Retinal fundus photograph: 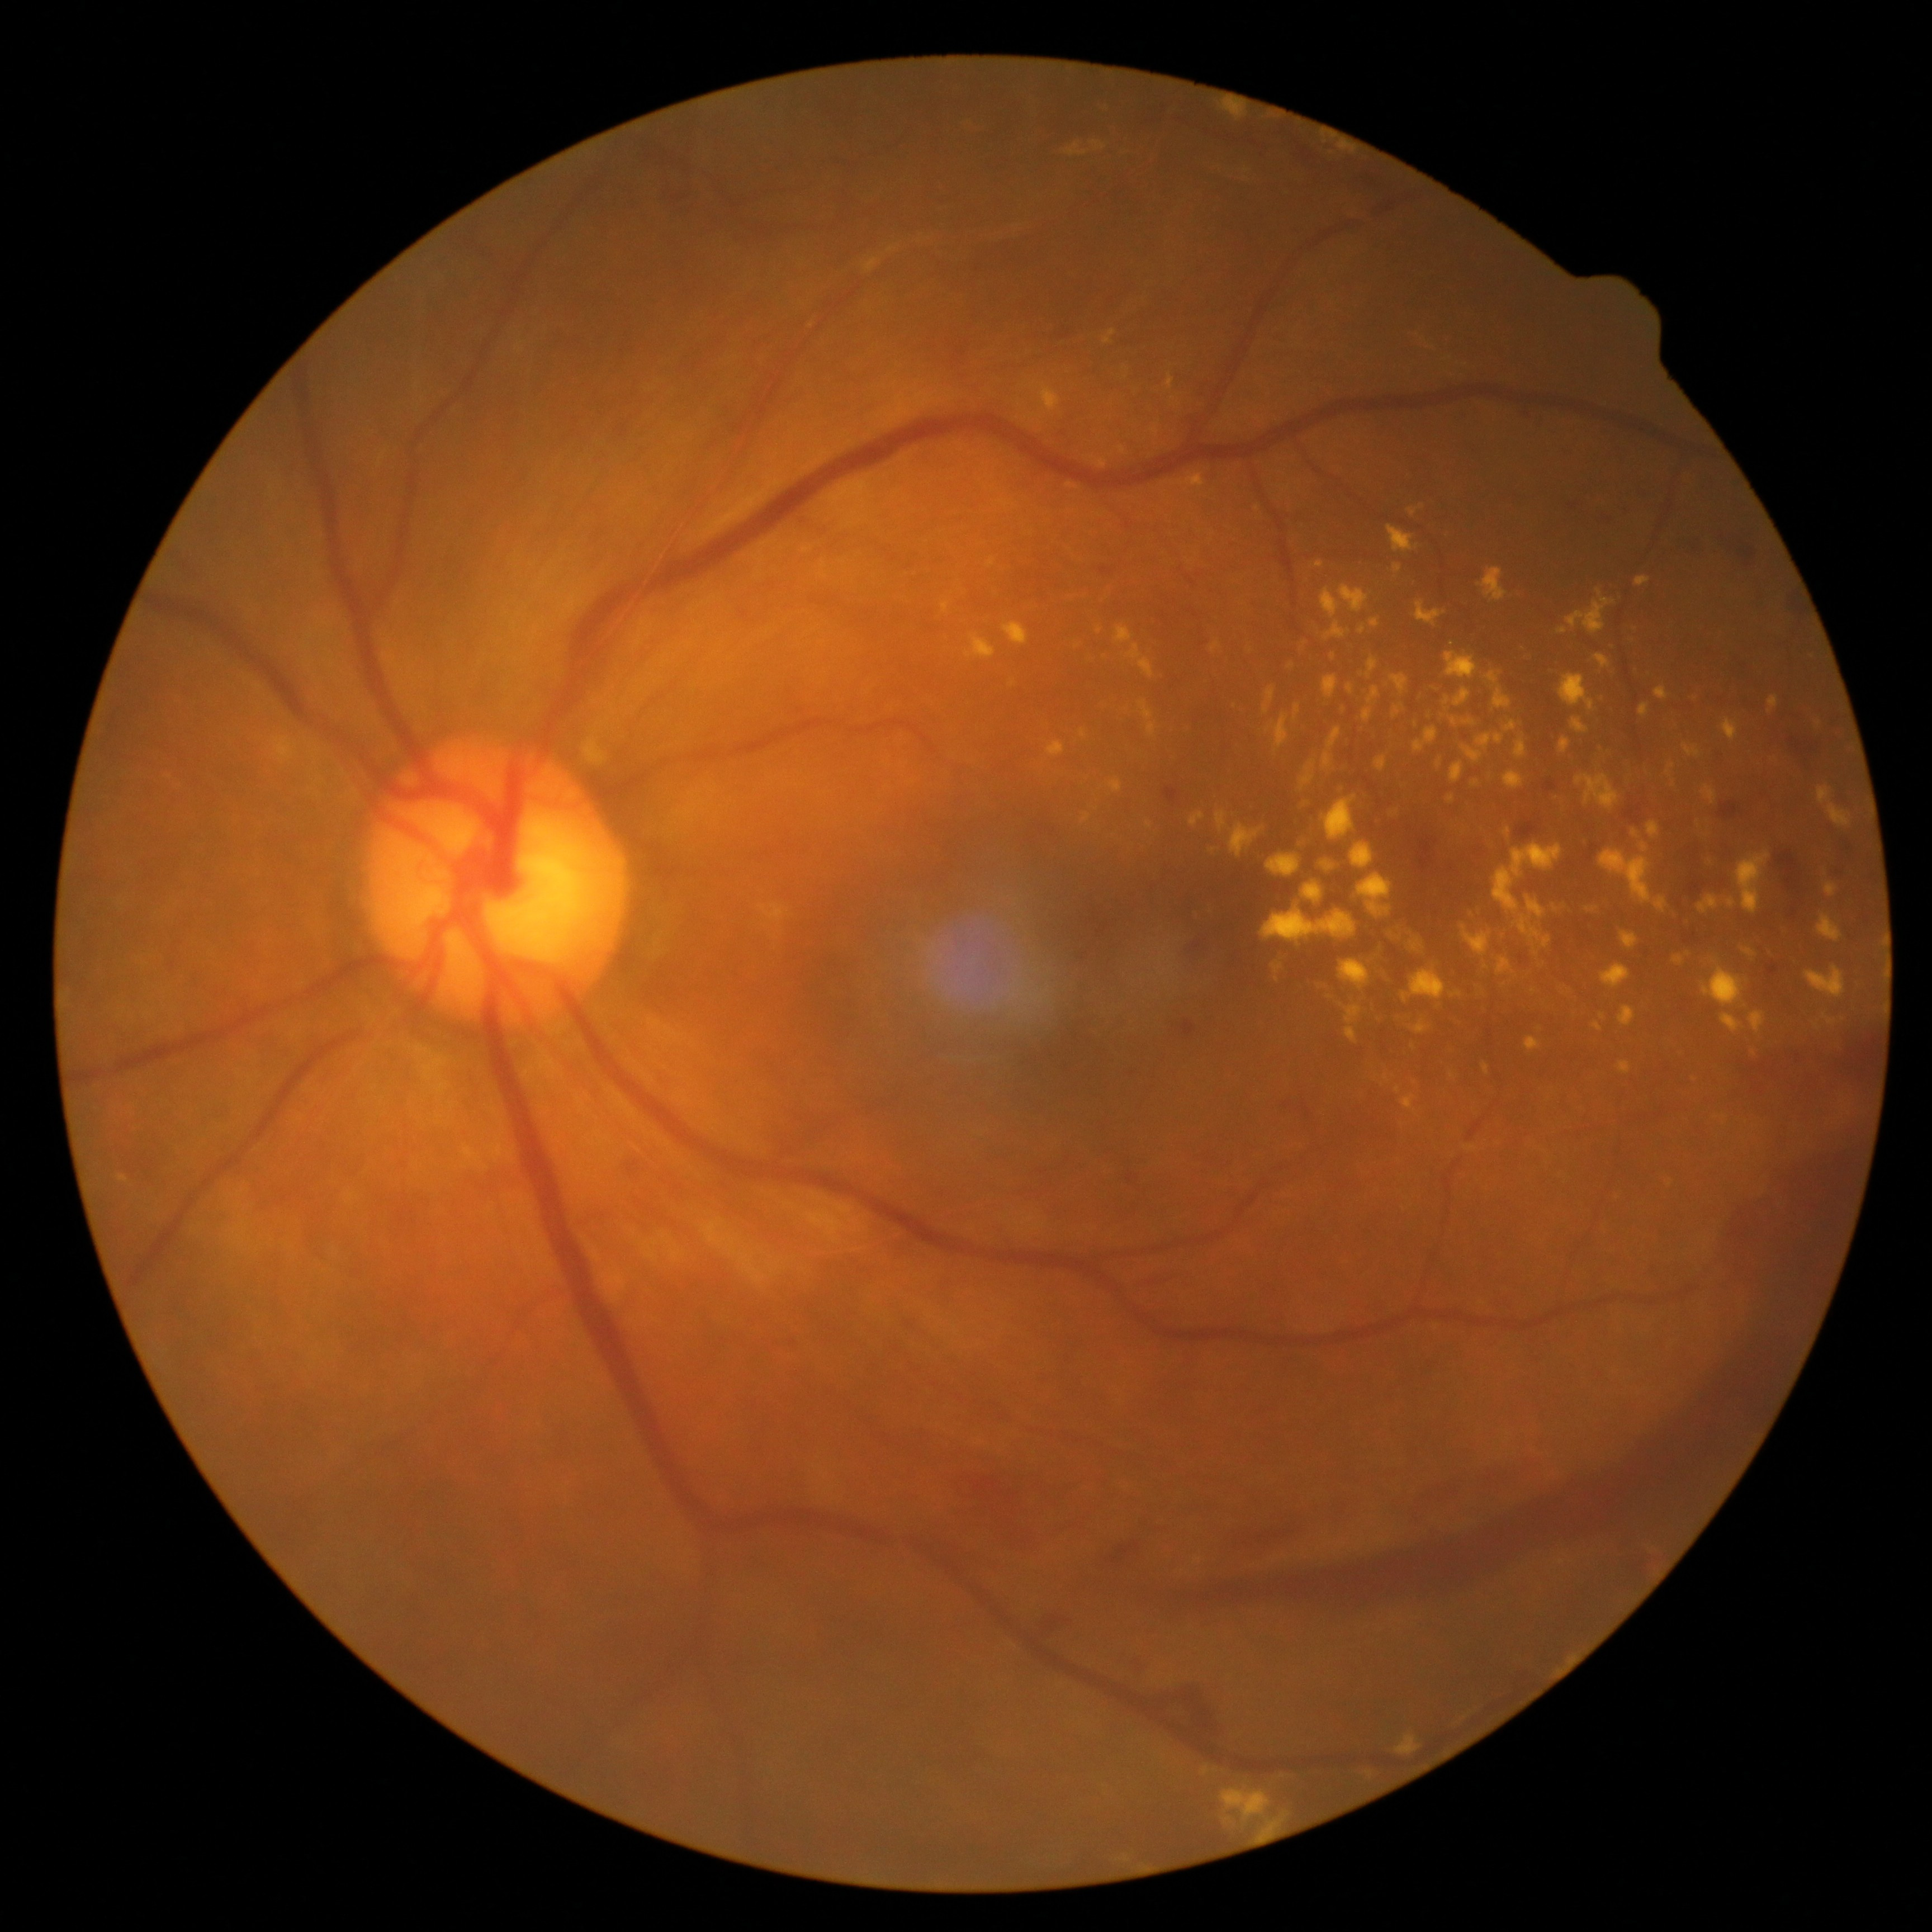
DR severity: 4/4
Representative lesions:
EXs (subset) = Rect(1425, 706, 1442, 718) | Rect(1749, 1011, 1765, 1033) | Rect(1702, 967, 1745, 1008) | Rect(1117, 697, 1125, 706) | Rect(1180, 473, 1206, 488) | Rect(1594, 654, 1612, 670) | Rect(1082, 812, 1091, 822) | Rect(1323, 860, 1336, 872) | Rect(1229, 822, 1263, 857) | Rect(1815, 721, 1823, 726) | Rect(1481, 982, 1493, 997) | Rect(1303, 882, 1323, 904) | Rect(1190, 812, 1206, 828) | Rect(1211, 641, 1220, 654) | Rect(1321, 588, 1341, 618) | Rect(1323, 727, 1342, 771)
EXs (small, approximate centers) near point(1070, 486) | point(1673, 783) | point(1123, 450)